Image size 2212x1659 · CFP:
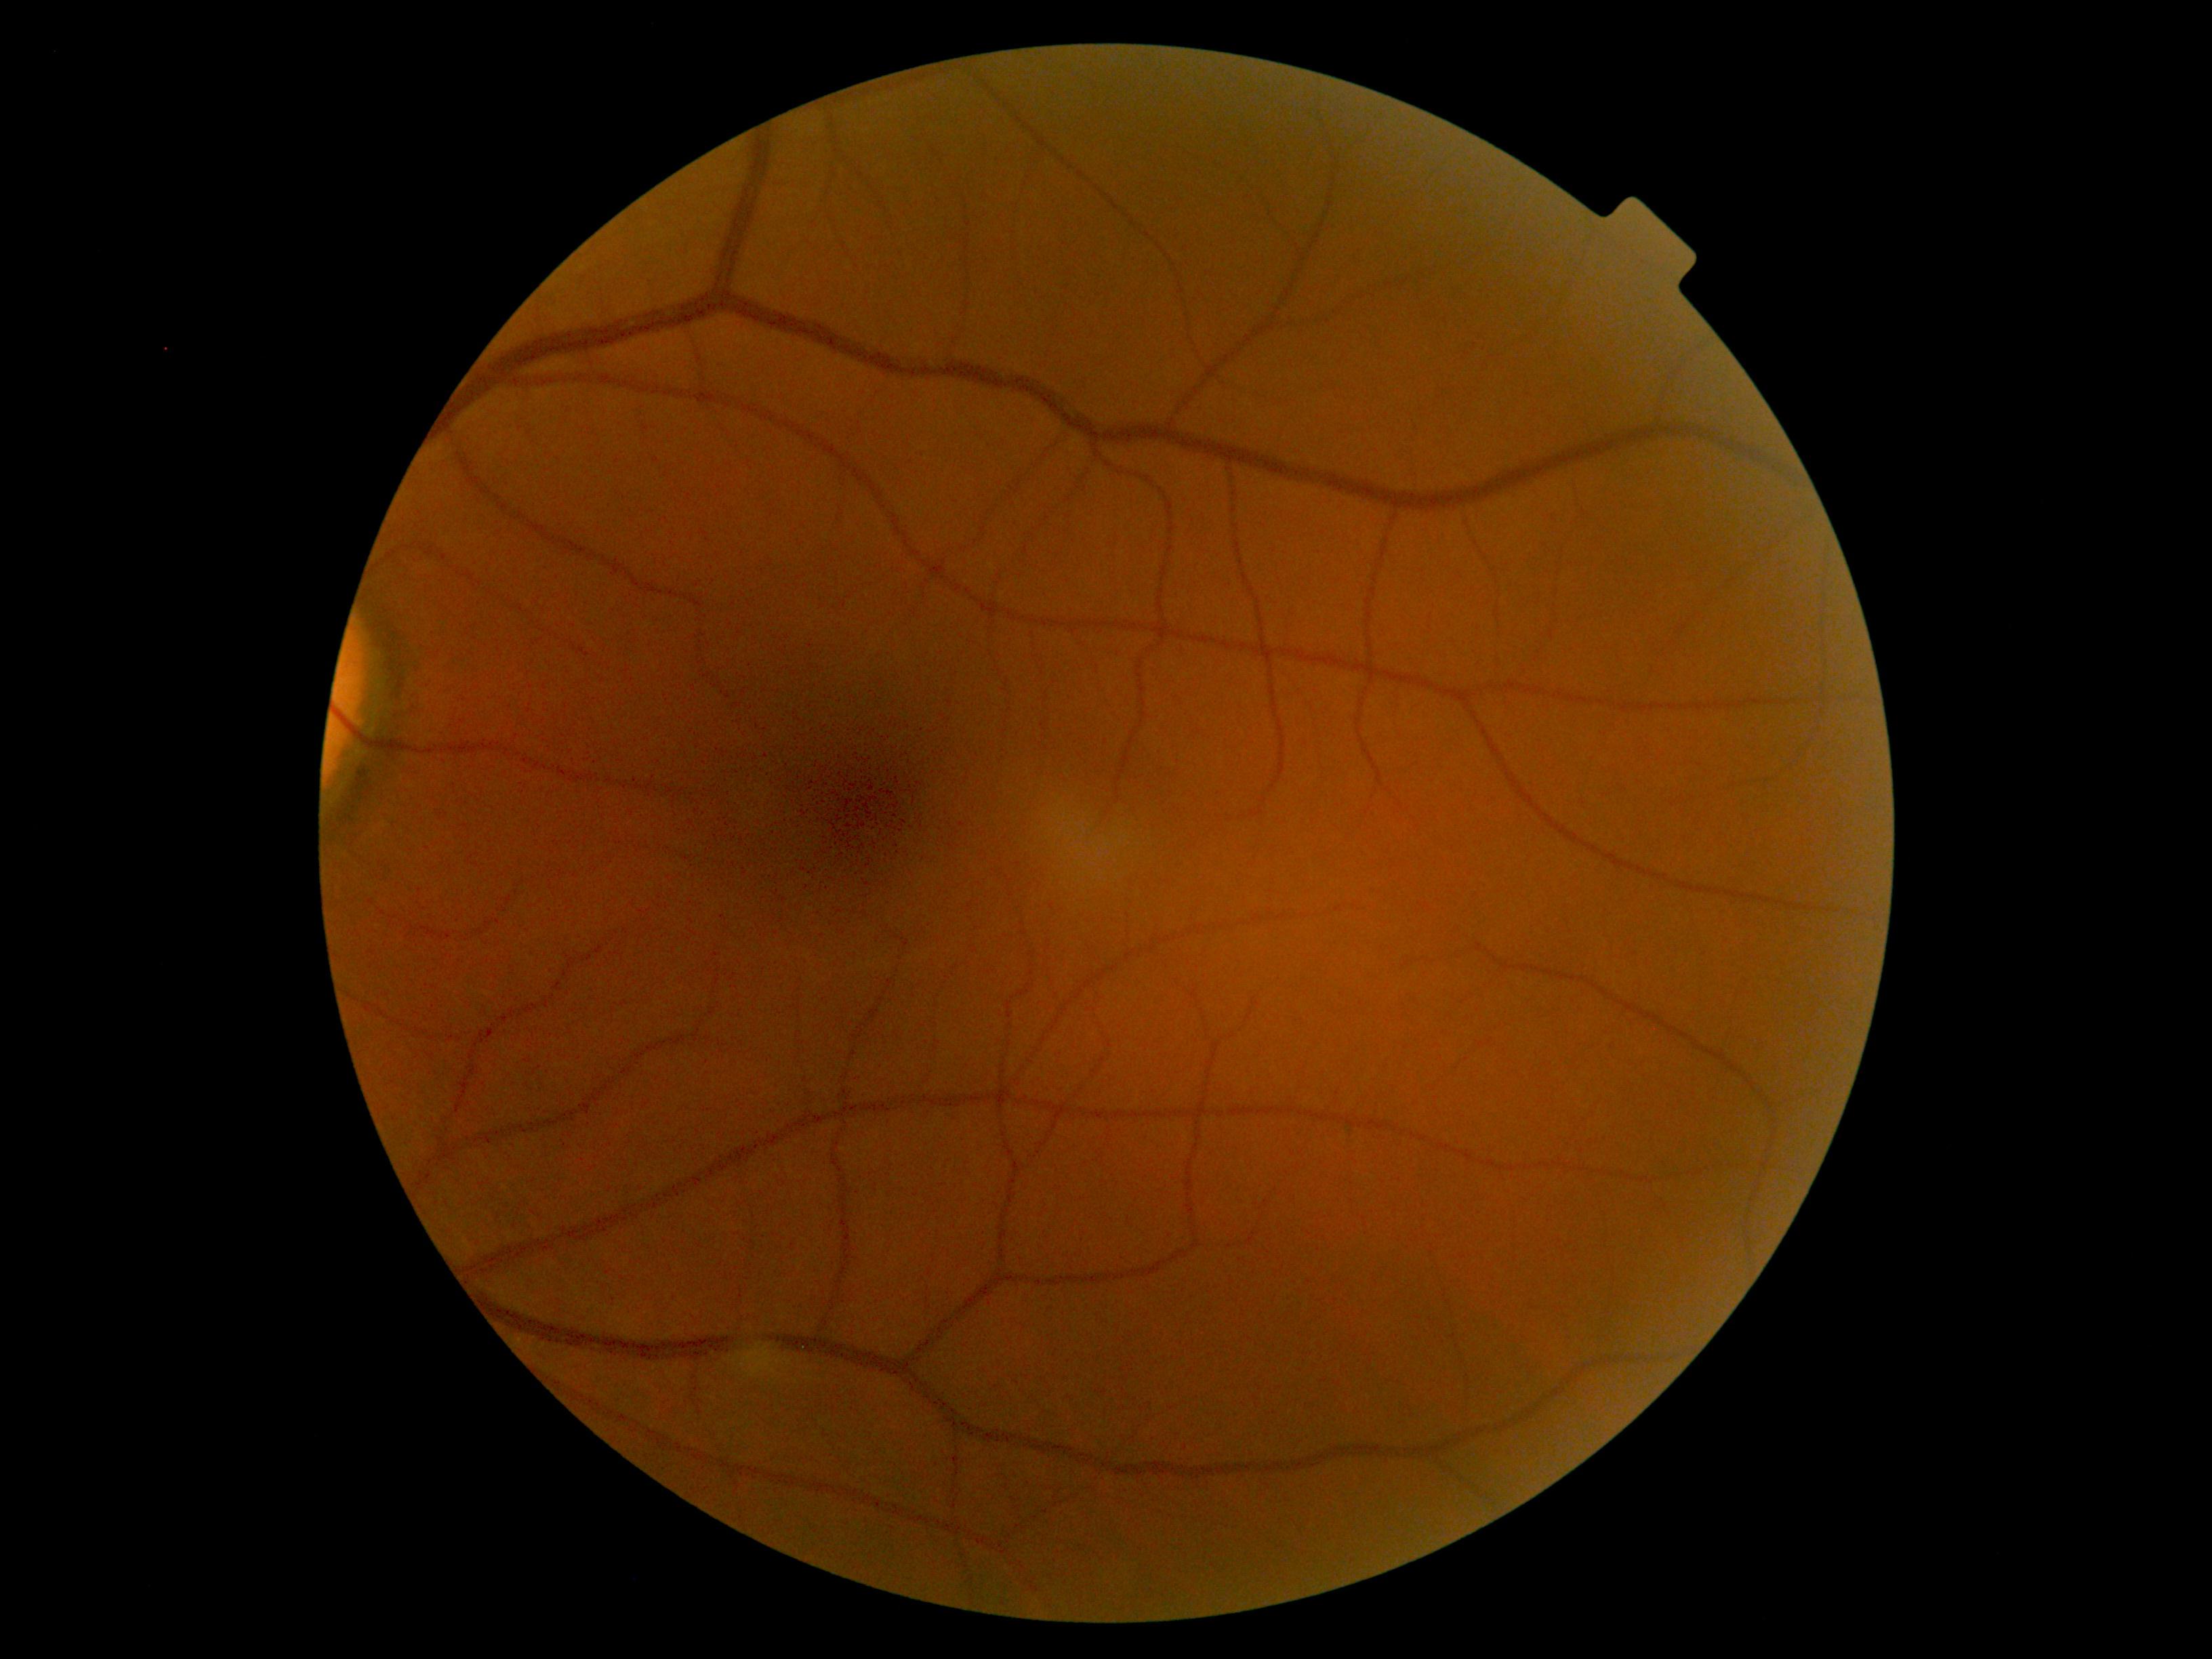

Retinopathy is no apparent diabetic retinopathy (grade 0).